Without pupil dilation, acquired with a NIDEK AFC-230, 848x848, retinal fundus photograph — 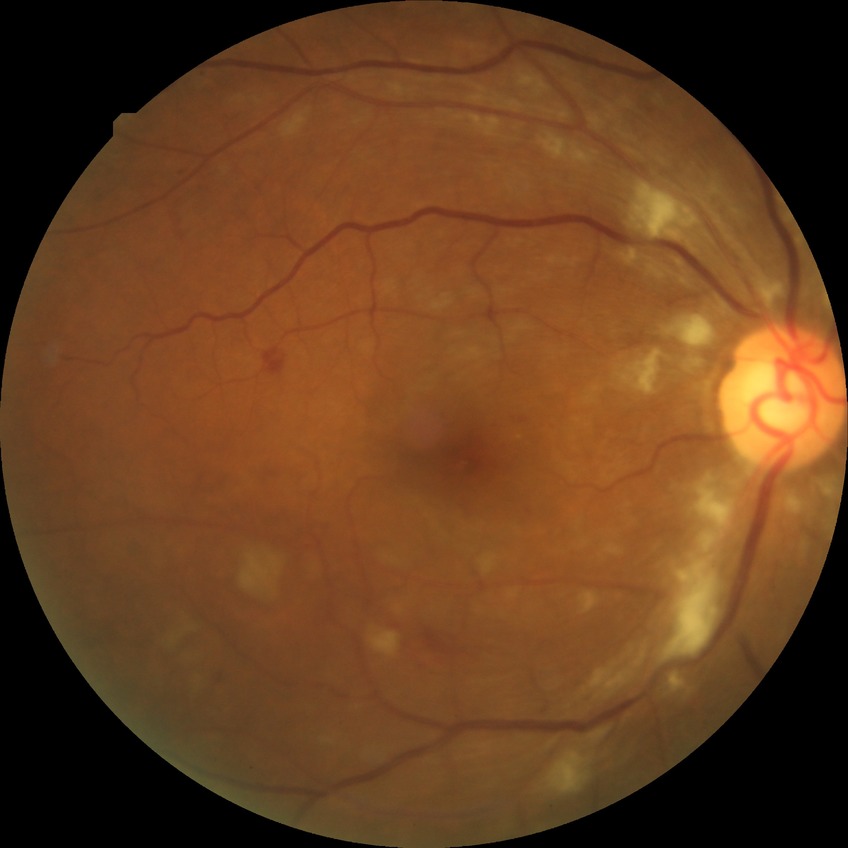 Davis grading: pre-proliferative diabetic retinopathy.